848 by 848 pixels; FOV: 45 degrees; graded on the modified Davis scale; no pharmacologic dilation; acquired with a NIDEK AFC-230; retinal fundus photograph
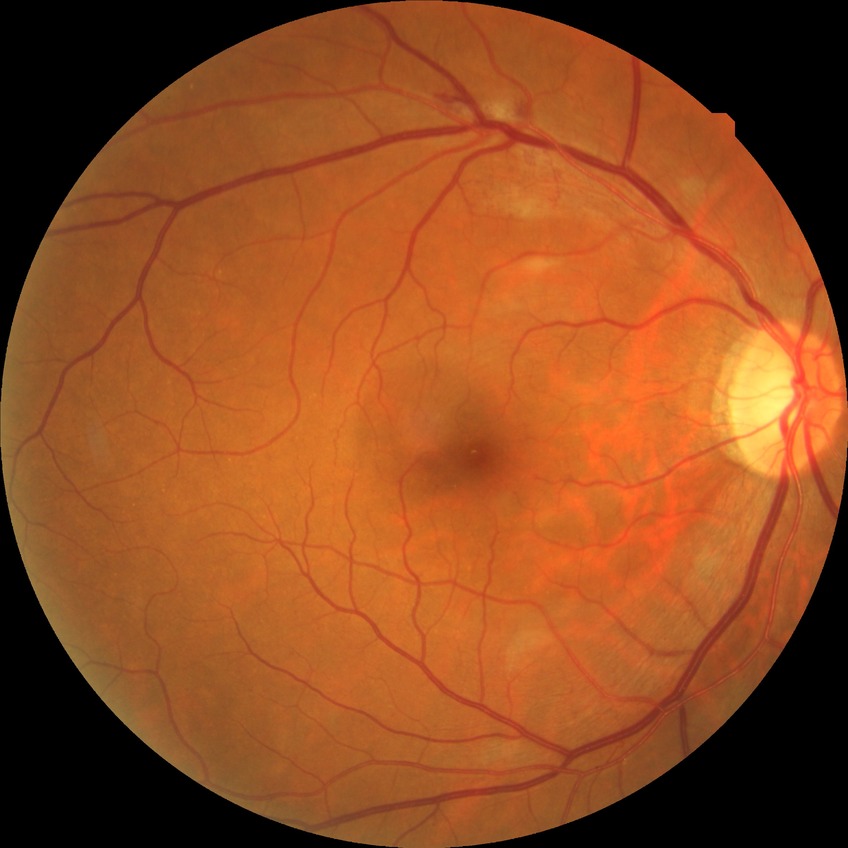
Diabetic retinopathy (DR): PPDR (pre-proliferative diabetic retinopathy).